Wide-field contact fundus photograph of an infant — 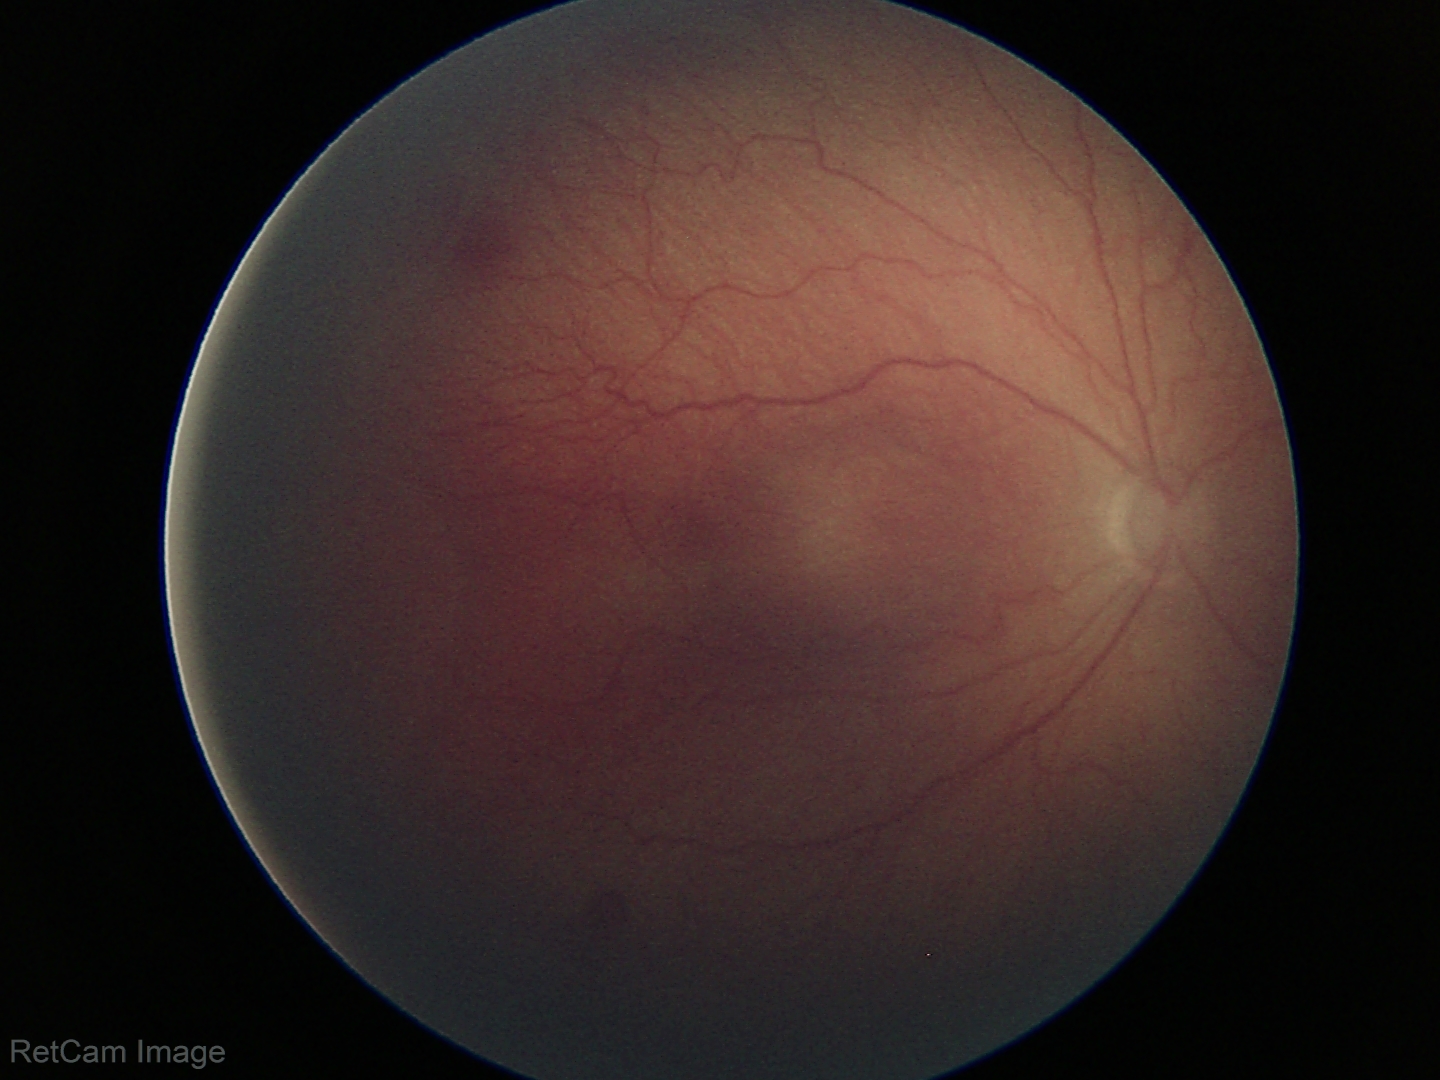
Q: Plus disease status?
A: no plus disease
Q: What is the diagnosis from this examination?
A: retinopathy of prematurity (ROP) stage 2